1240 x 1240 pixels. Phoenix ICON wide-field infant fundus image.
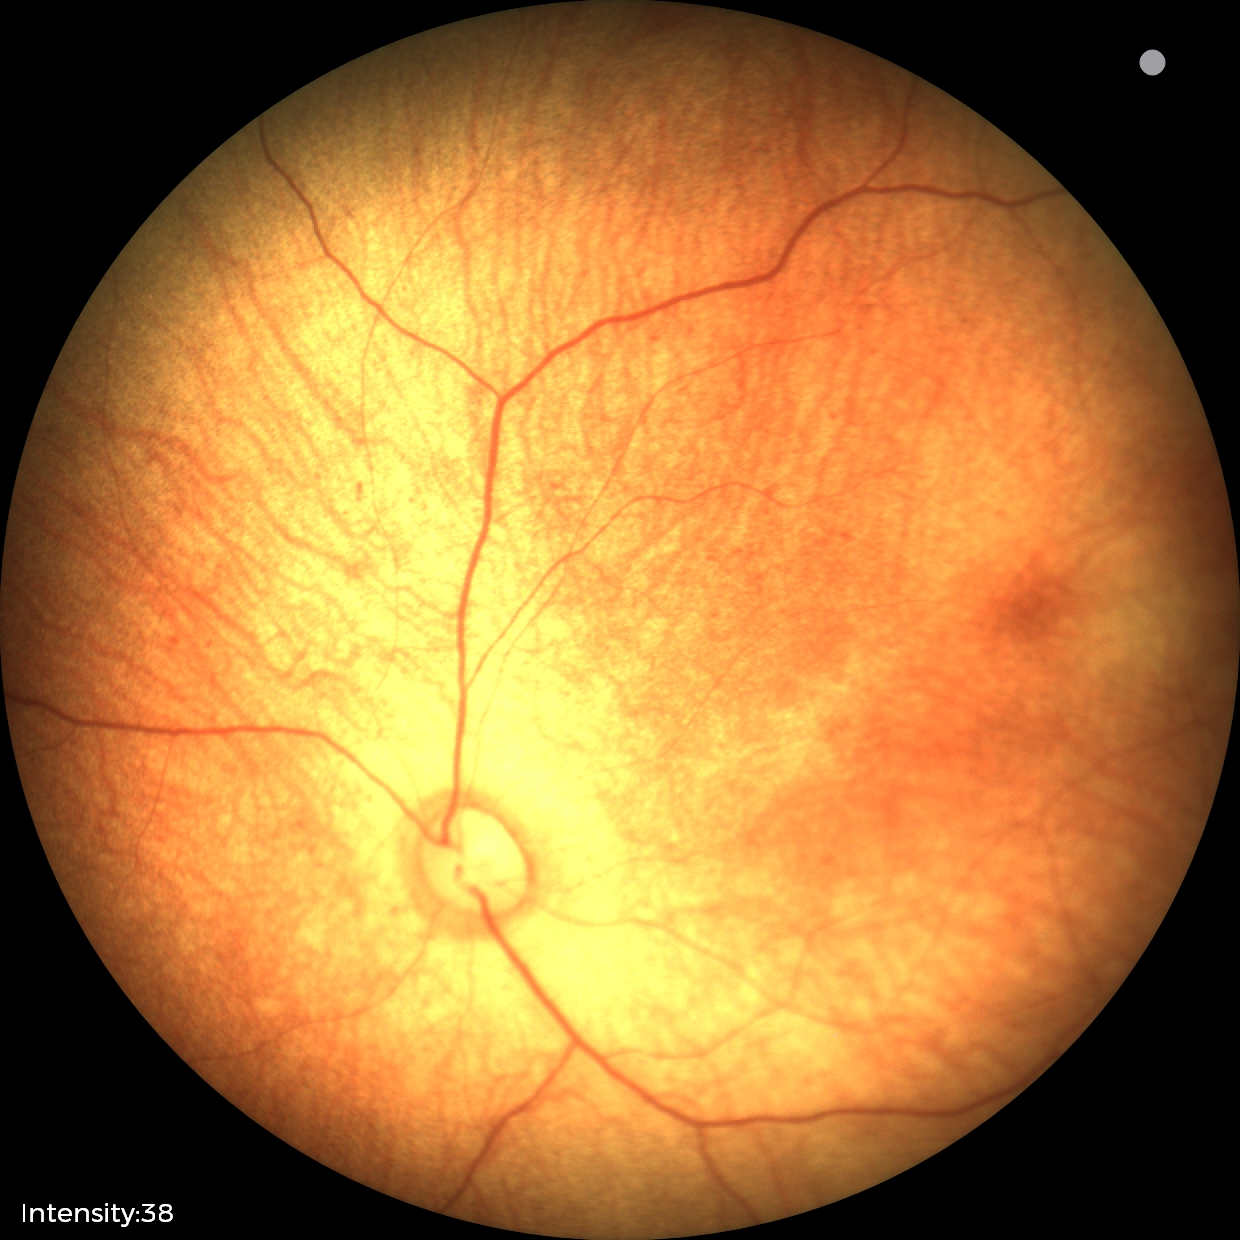 Q: What is the screening diagnosis?
A: normal fundus examination